2352x1568px; fundus photo; 45° field of view
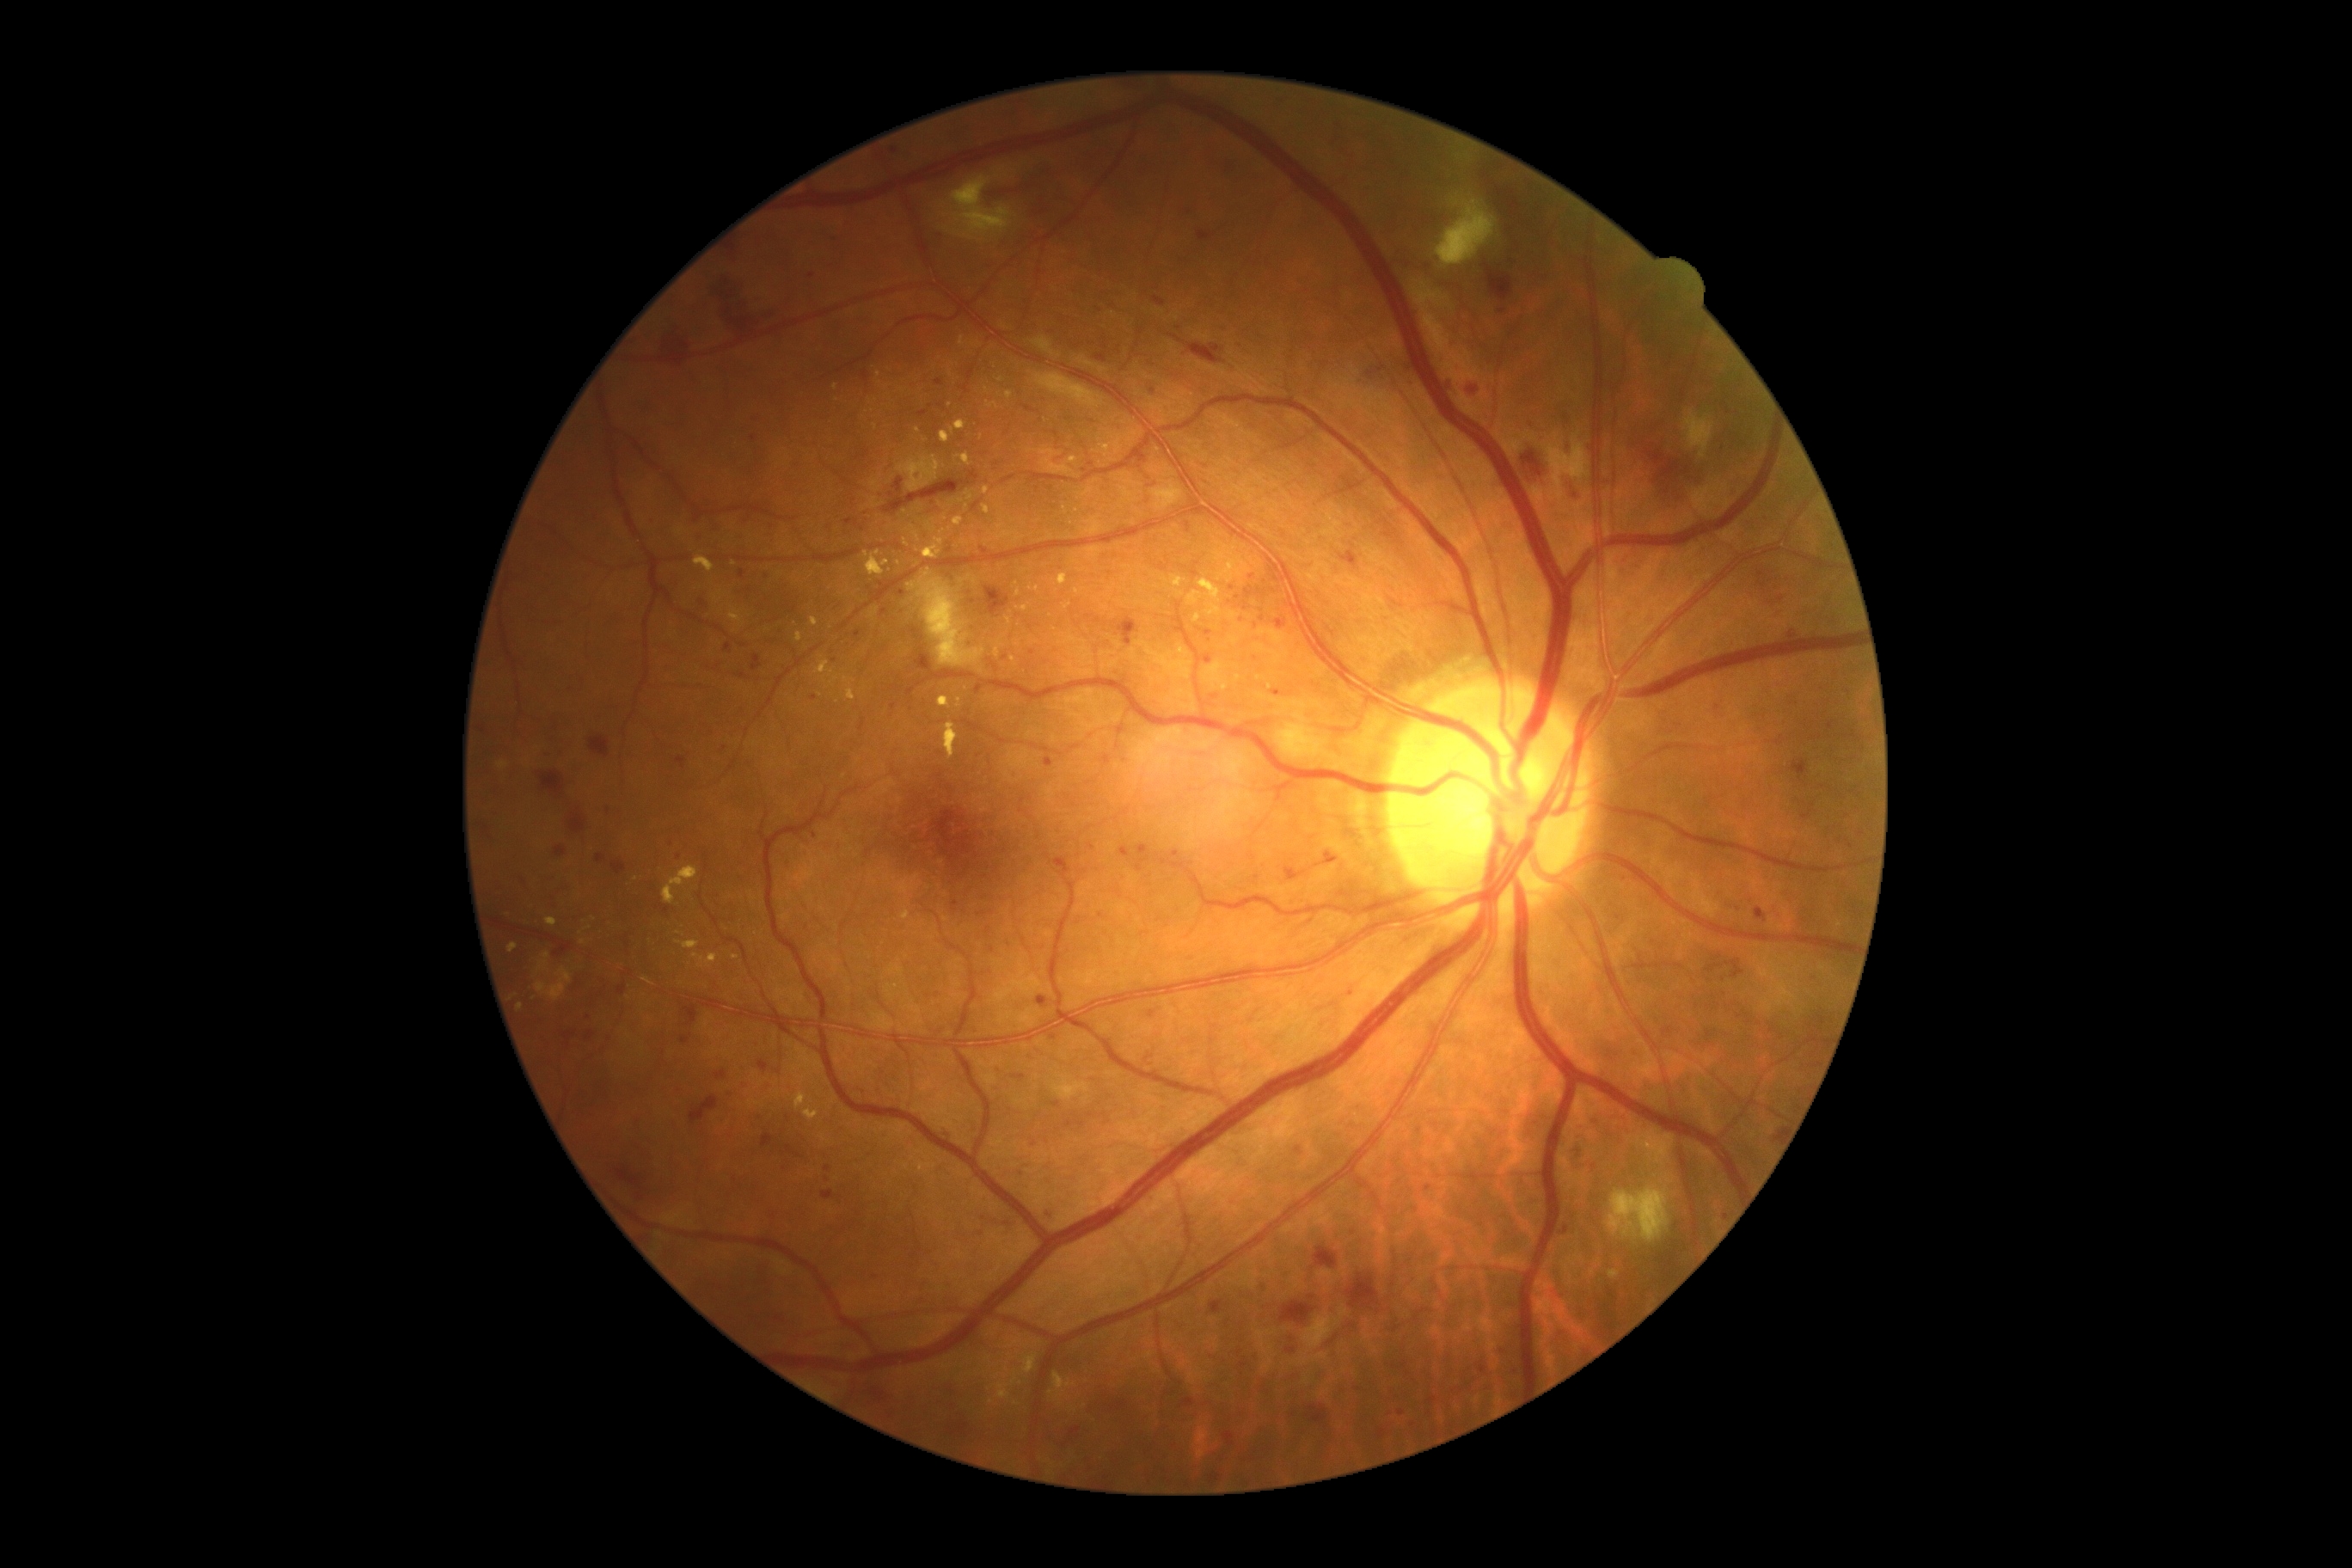
Diabetic retinopathy (DR) is severe NPDR (grade 3); non-proliferative diabetic retinopathy. Soft exudates (SEs) located at (1608,1187,1670,1244); (1541,434,1591,501); (907,570,986,668); (952,176,1012,240); (1684,410,1715,458); (1436,195,1497,267). Hard exudates (EXs) include (983,505,989,515); (1007,391,1014,400); (903,539,910,548); (867,498,881,508); (952,420,965,434); (663,866,699,905); (816,661,833,677); (508,943,518,953); (957,453,972,467); (943,723,959,759); (847,689,855,701). Additional small EXs near [520, 1008]; [515, 997]; [967, 507]; [1025, 608]; [1037, 589]; [905, 511]; [942, 533]; [945, 518]. Hemorrhages (HEs) include (658,328,692,350); (1306,1406,1328,1426); (1223,1433,1235,1445); (618,1170,640,1185); (1189,345,1225,364); (554,941,572,957); (885,472,981,515); (912,628,919,640); (1210,1302,1223,1314); (1170,334,1182,343); (1517,446,1550,486); (1565,479,1579,501); (613,862,627,874); (1773,1132,1780,1141); (845,520,859,525); (714,1070,726,1081); (1057,854,1067,864). Microaneurysms (MAs) include (824,1165,831,1173); (1479,1366,1486,1375); (855,522,864,527); (738,570,747,580); (1273,690,1283,697); (677,759,685,768). Additional small MAs near [1718, 709]; [894, 151]; [1328, 853]; [811, 276]; [986, 877]; [982, 1216]; [1379, 369]; [1262, 620]; [1035, 1145]; [894, 707]; [835, 239].